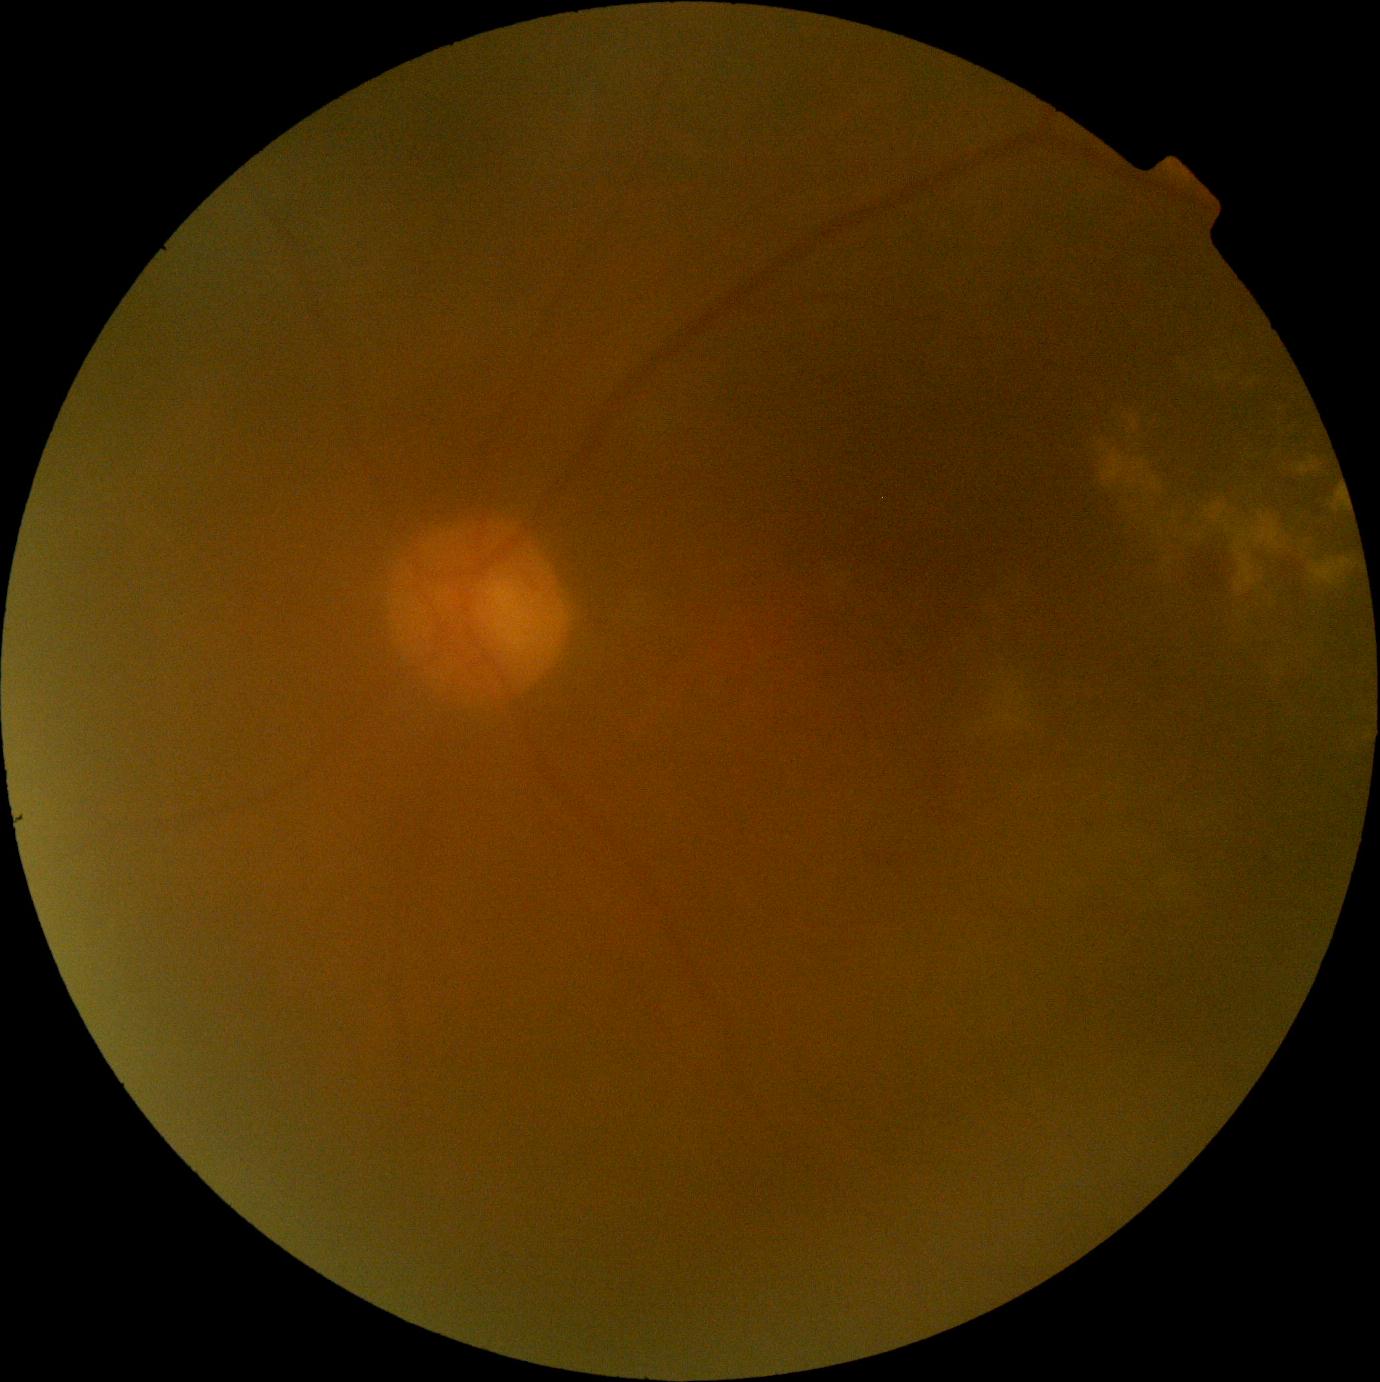

Diabetic retinopathy grade: 2. The retinopathy is classified as non-proliferative diabetic retinopathy.